NIDEK AFC-230 fundus camera
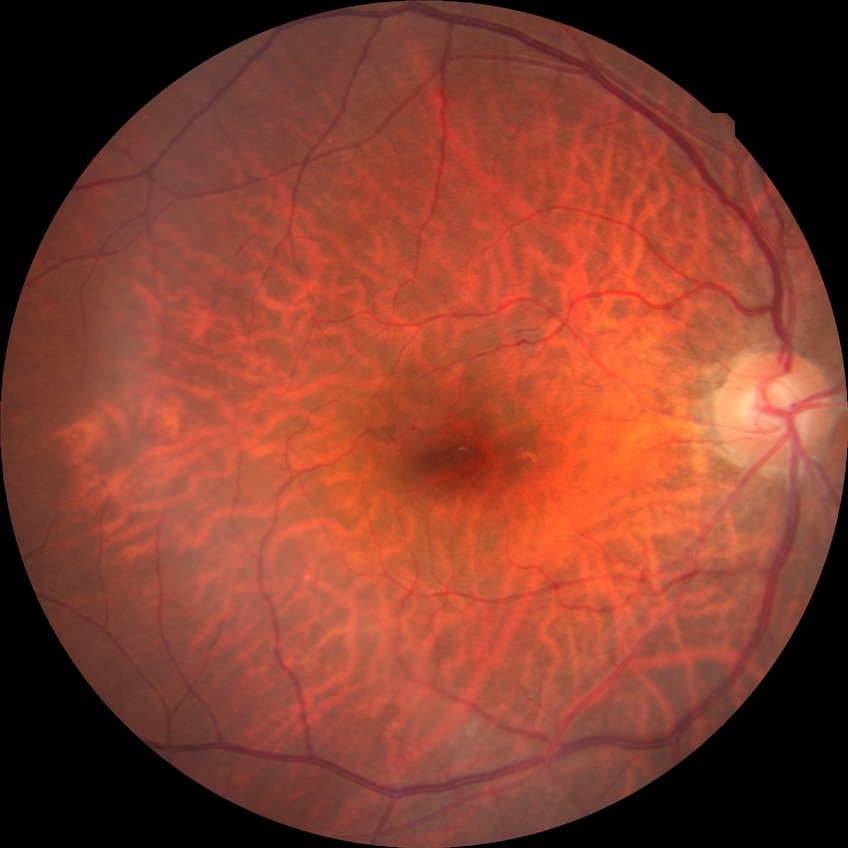 diabetic retinopathy (DR): simple diabetic retinopathy (SDR).